2352x1568, retinal fundus photograph
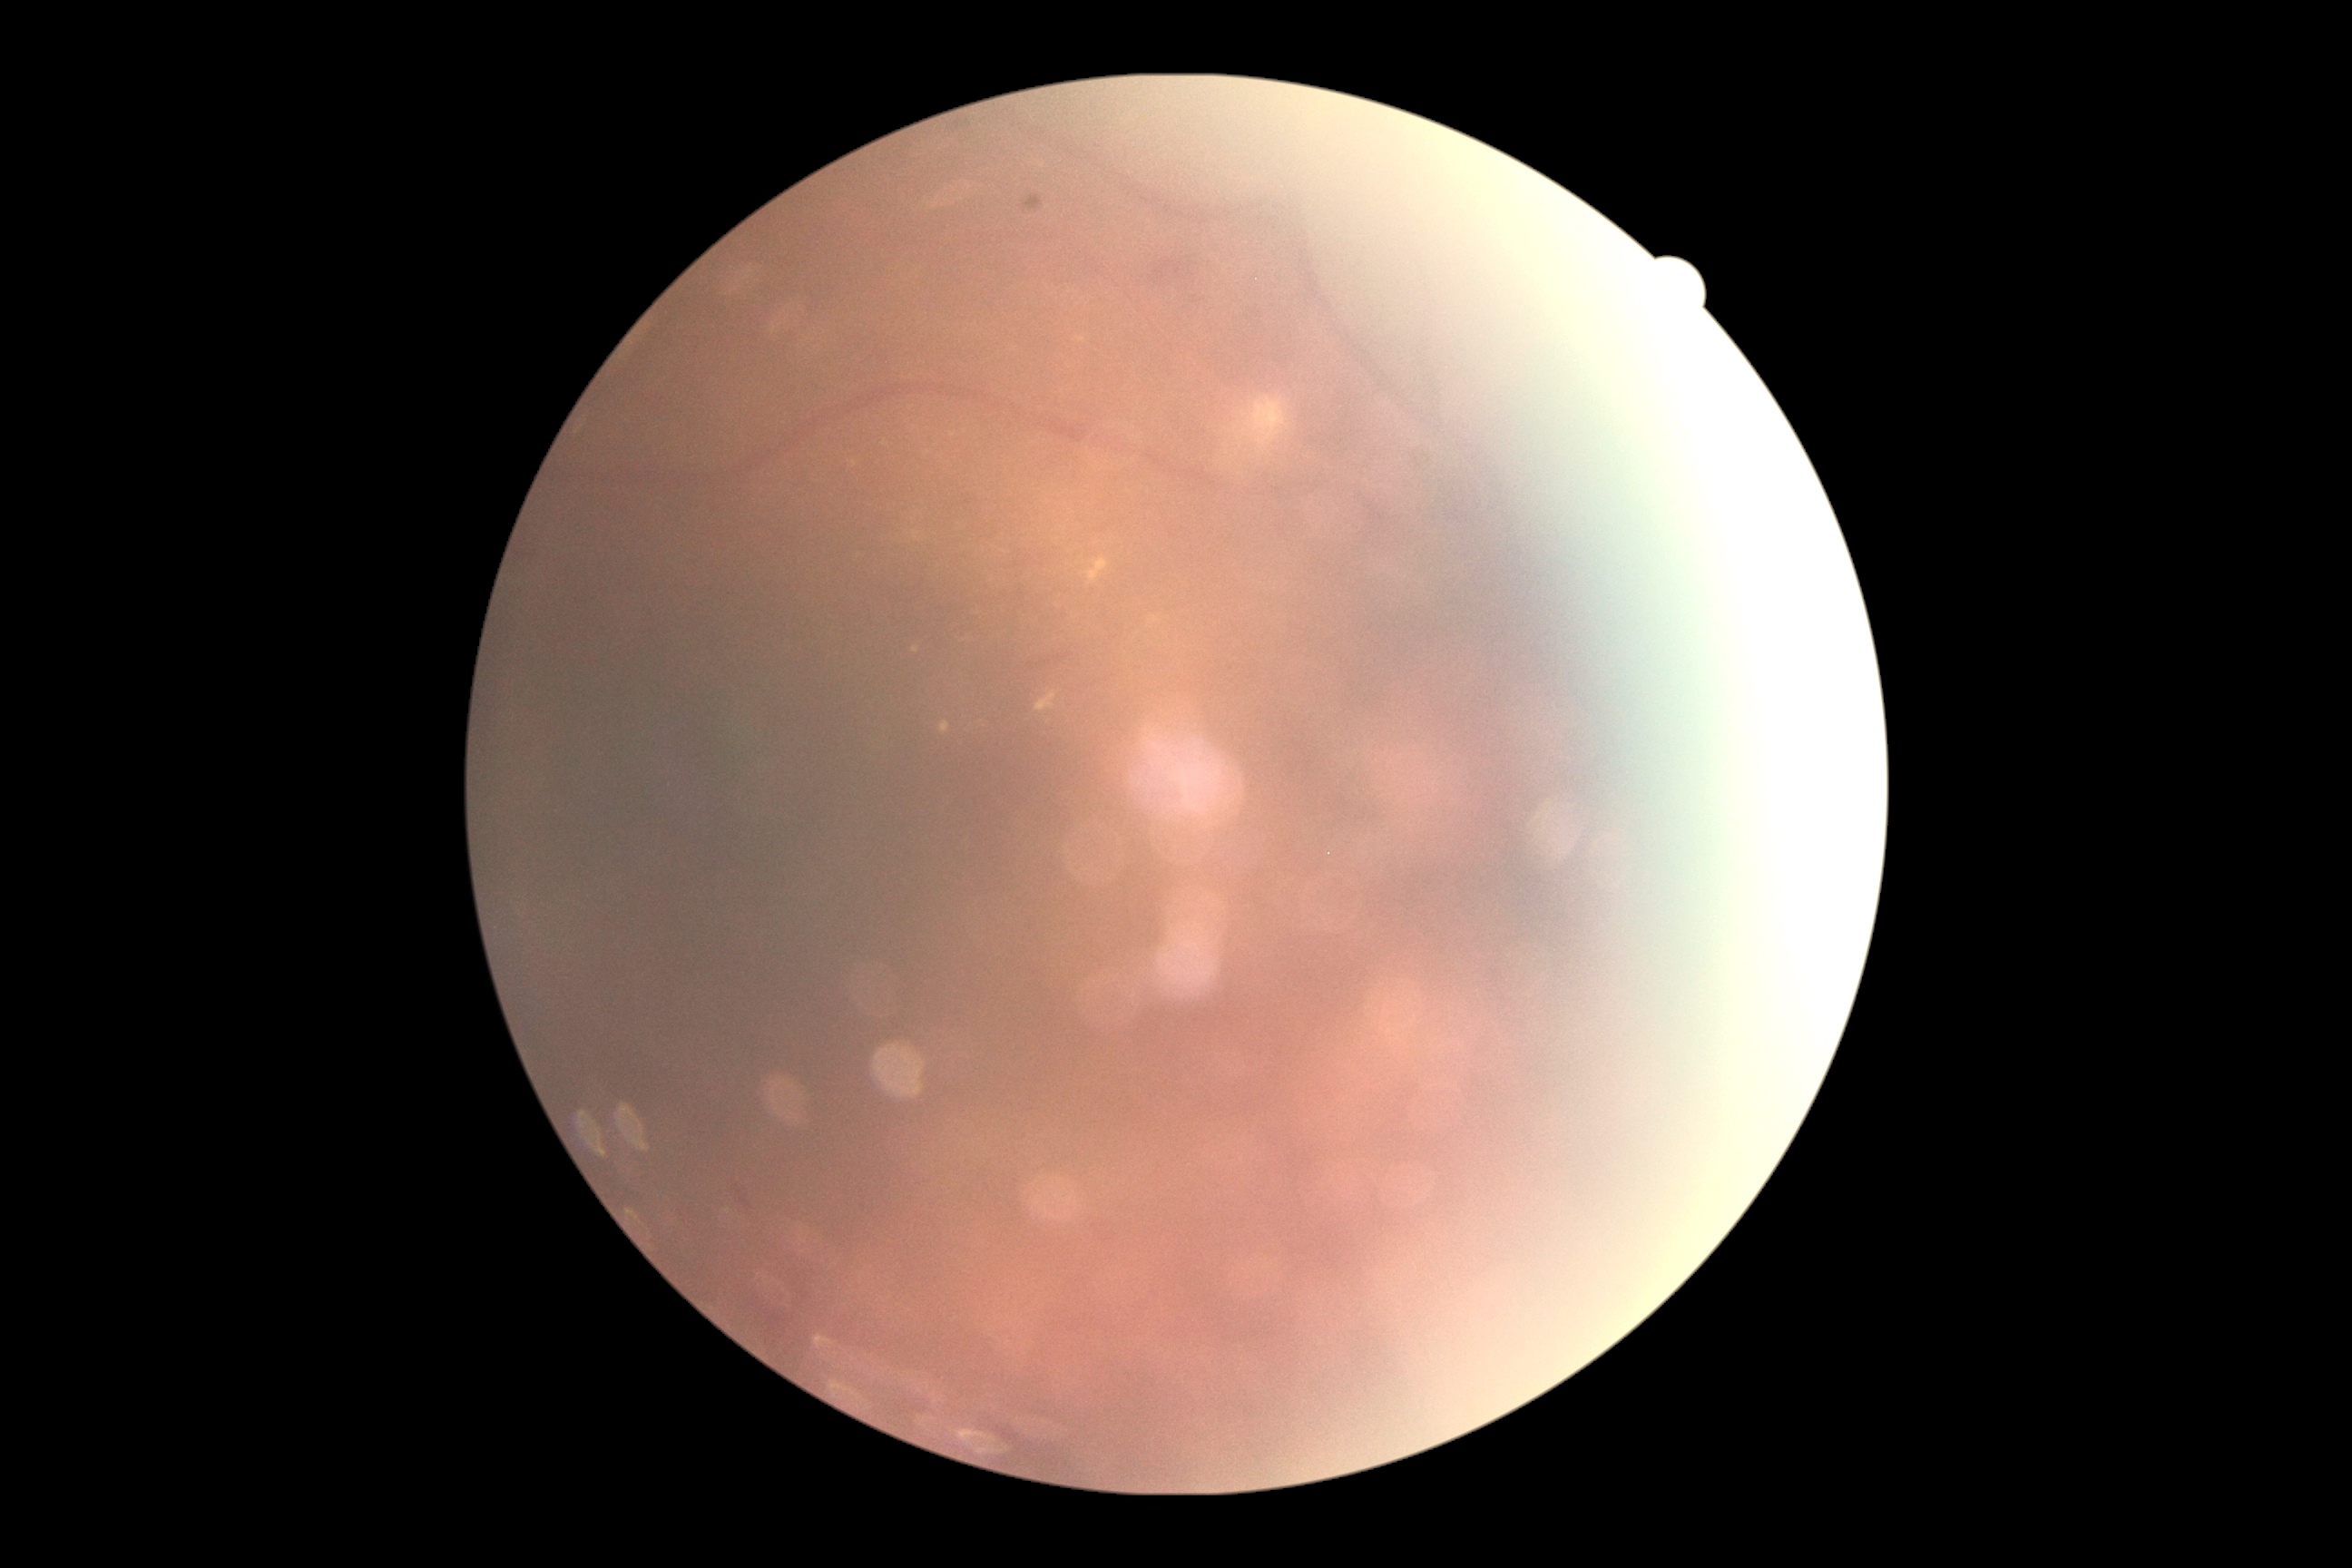
DR severity is grade 2 (moderate NPDR).
The retinopathy is classified as non-proliferative diabetic retinopathy.